2048 x 1536 pixels: 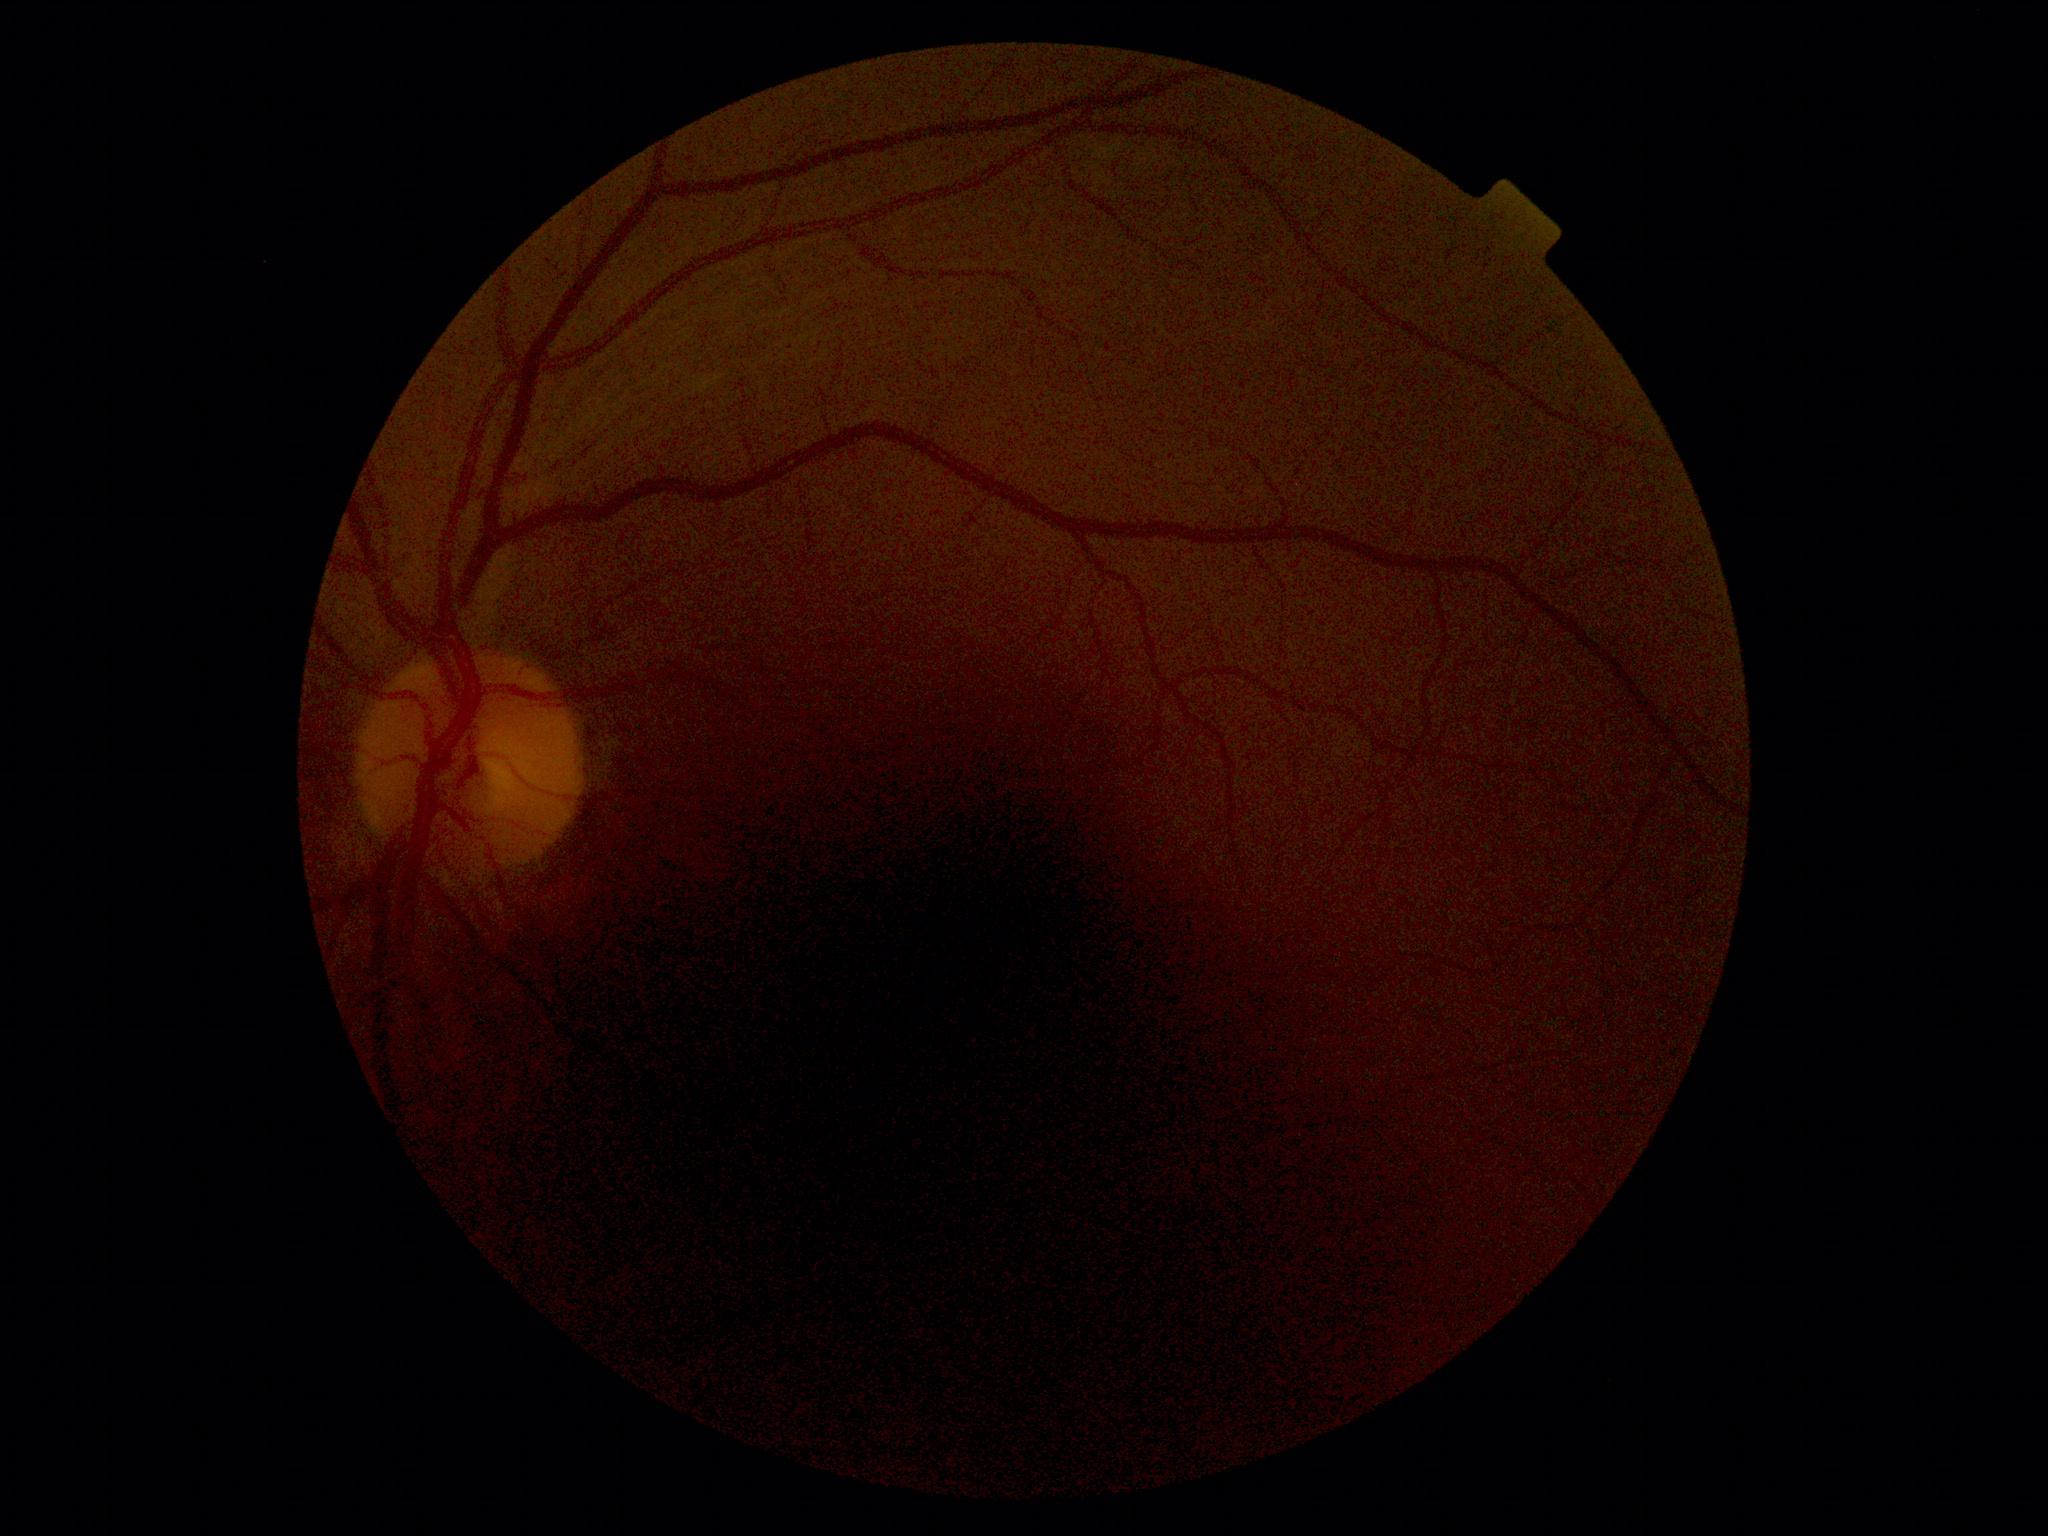 DR stage=0/4.